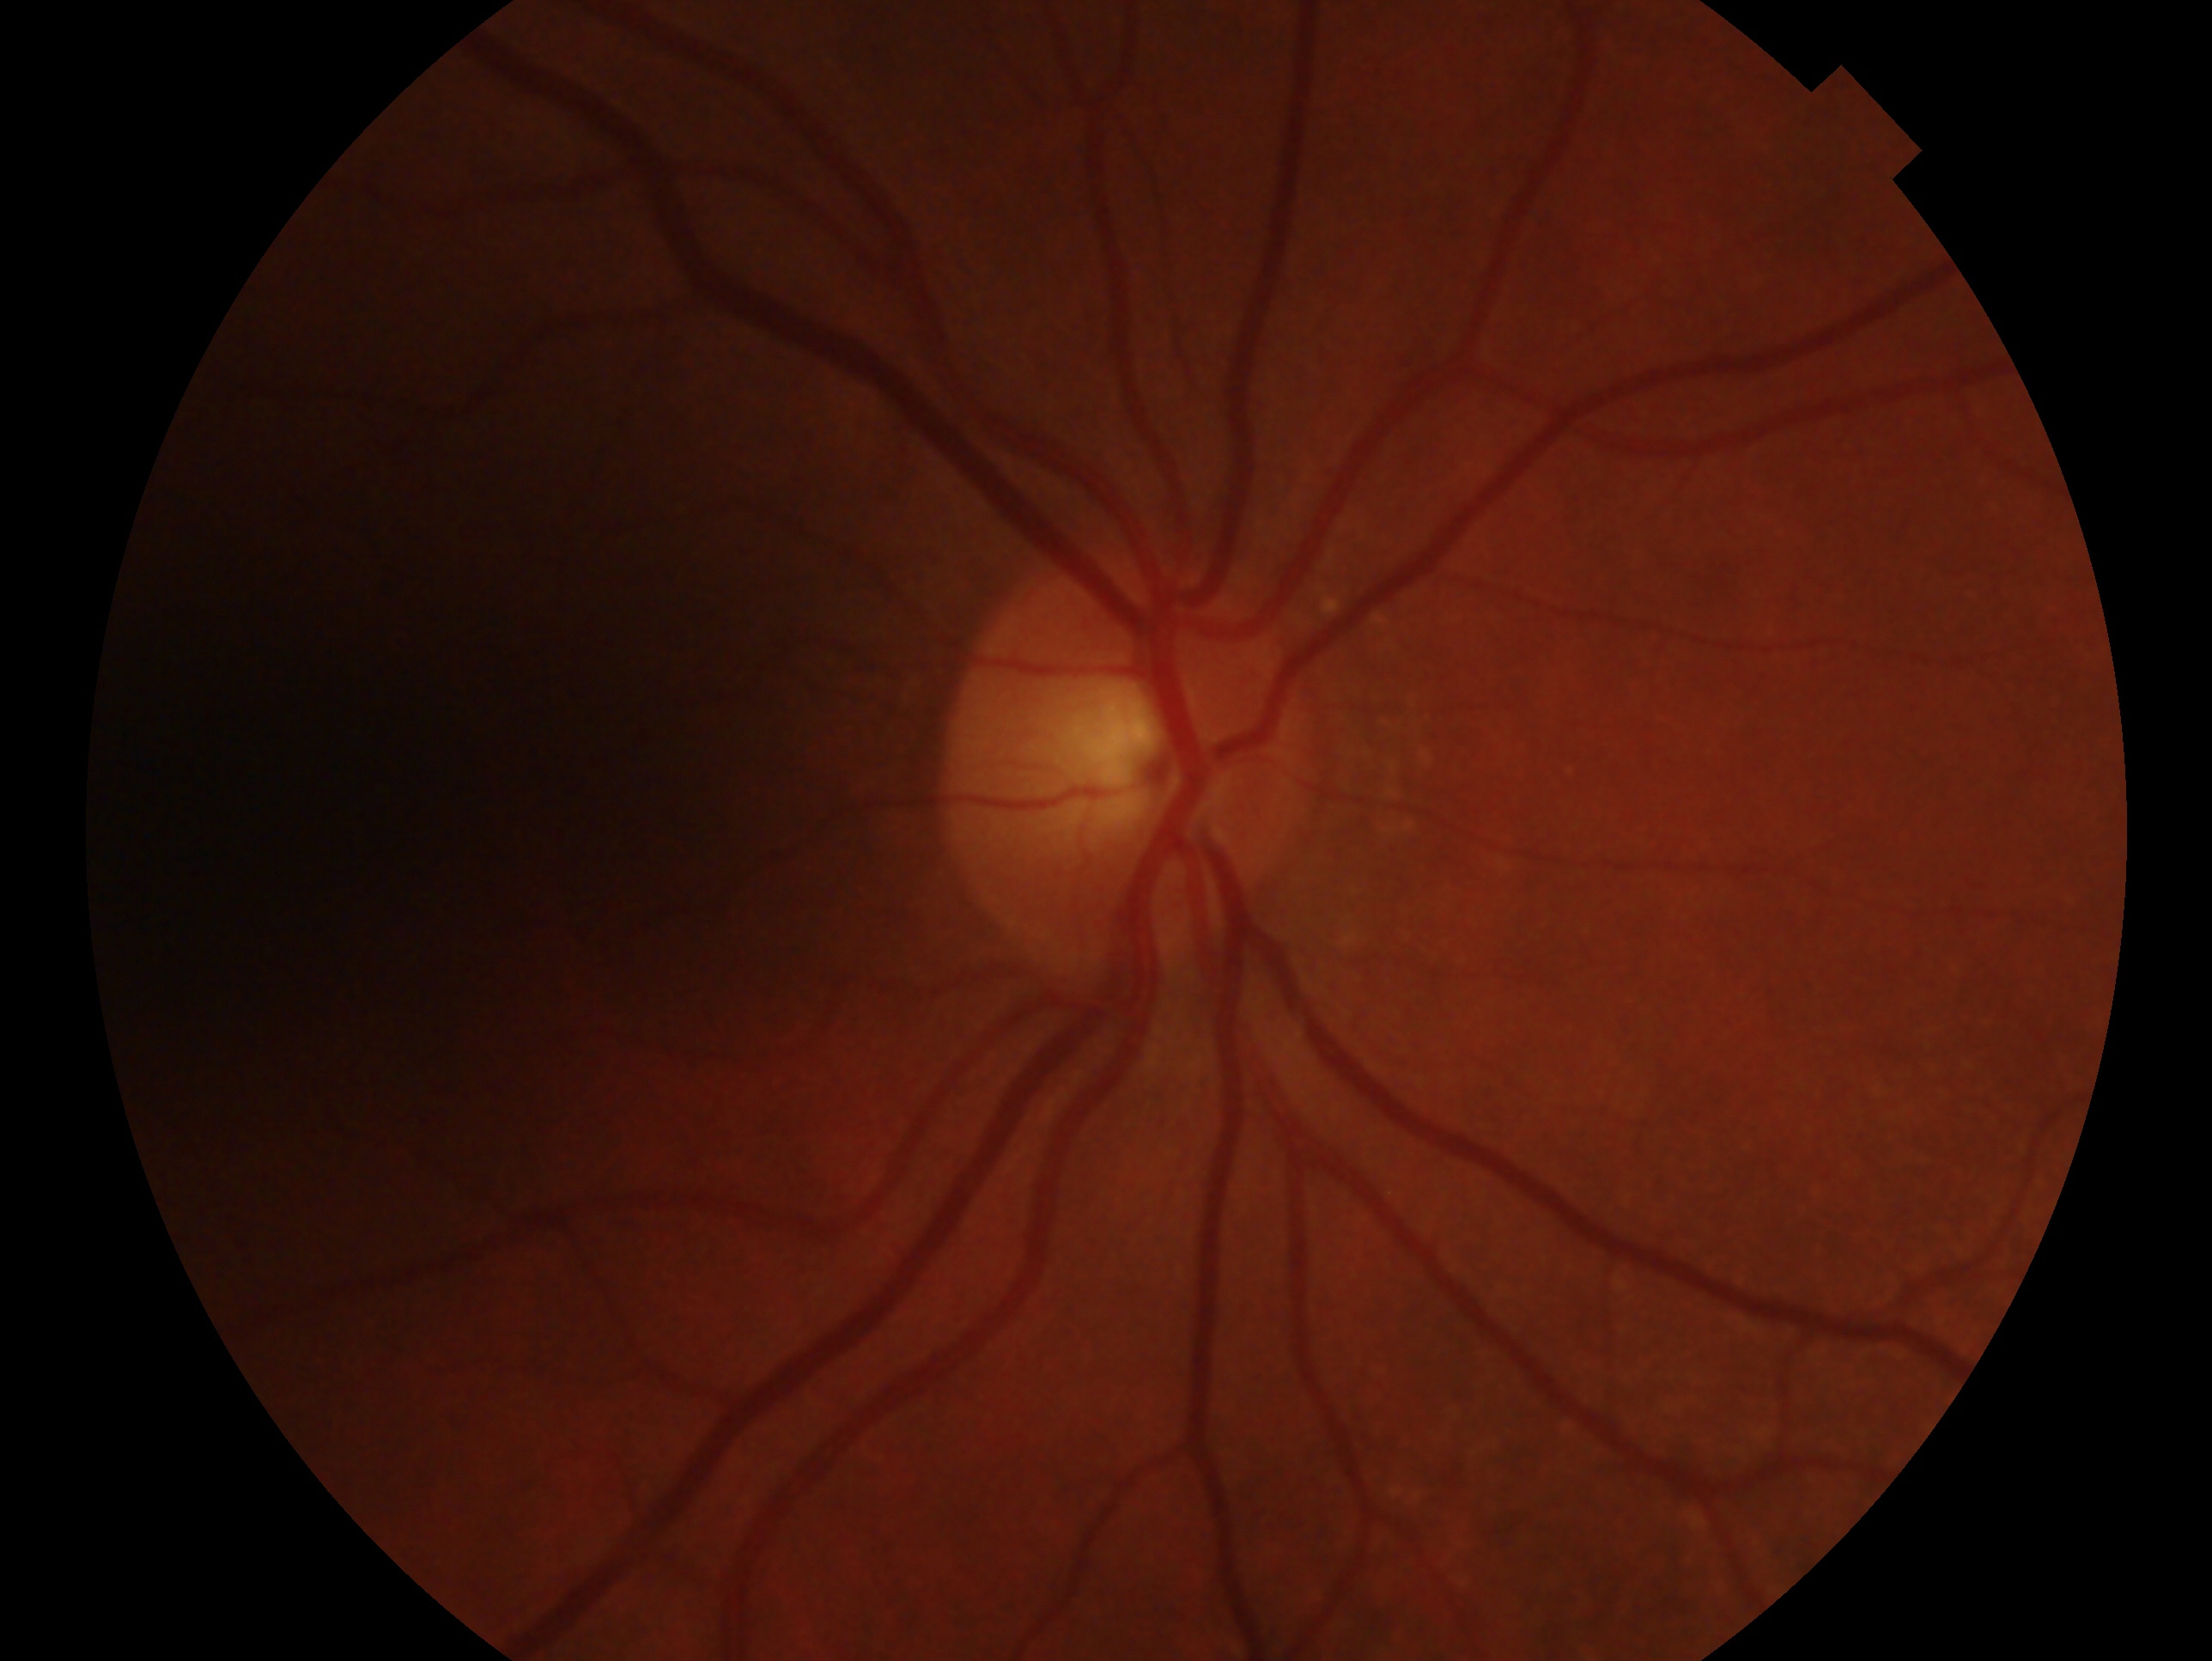

Assessment: no evidence of glaucoma. The image shows the OD.